Image size 2352x1568.
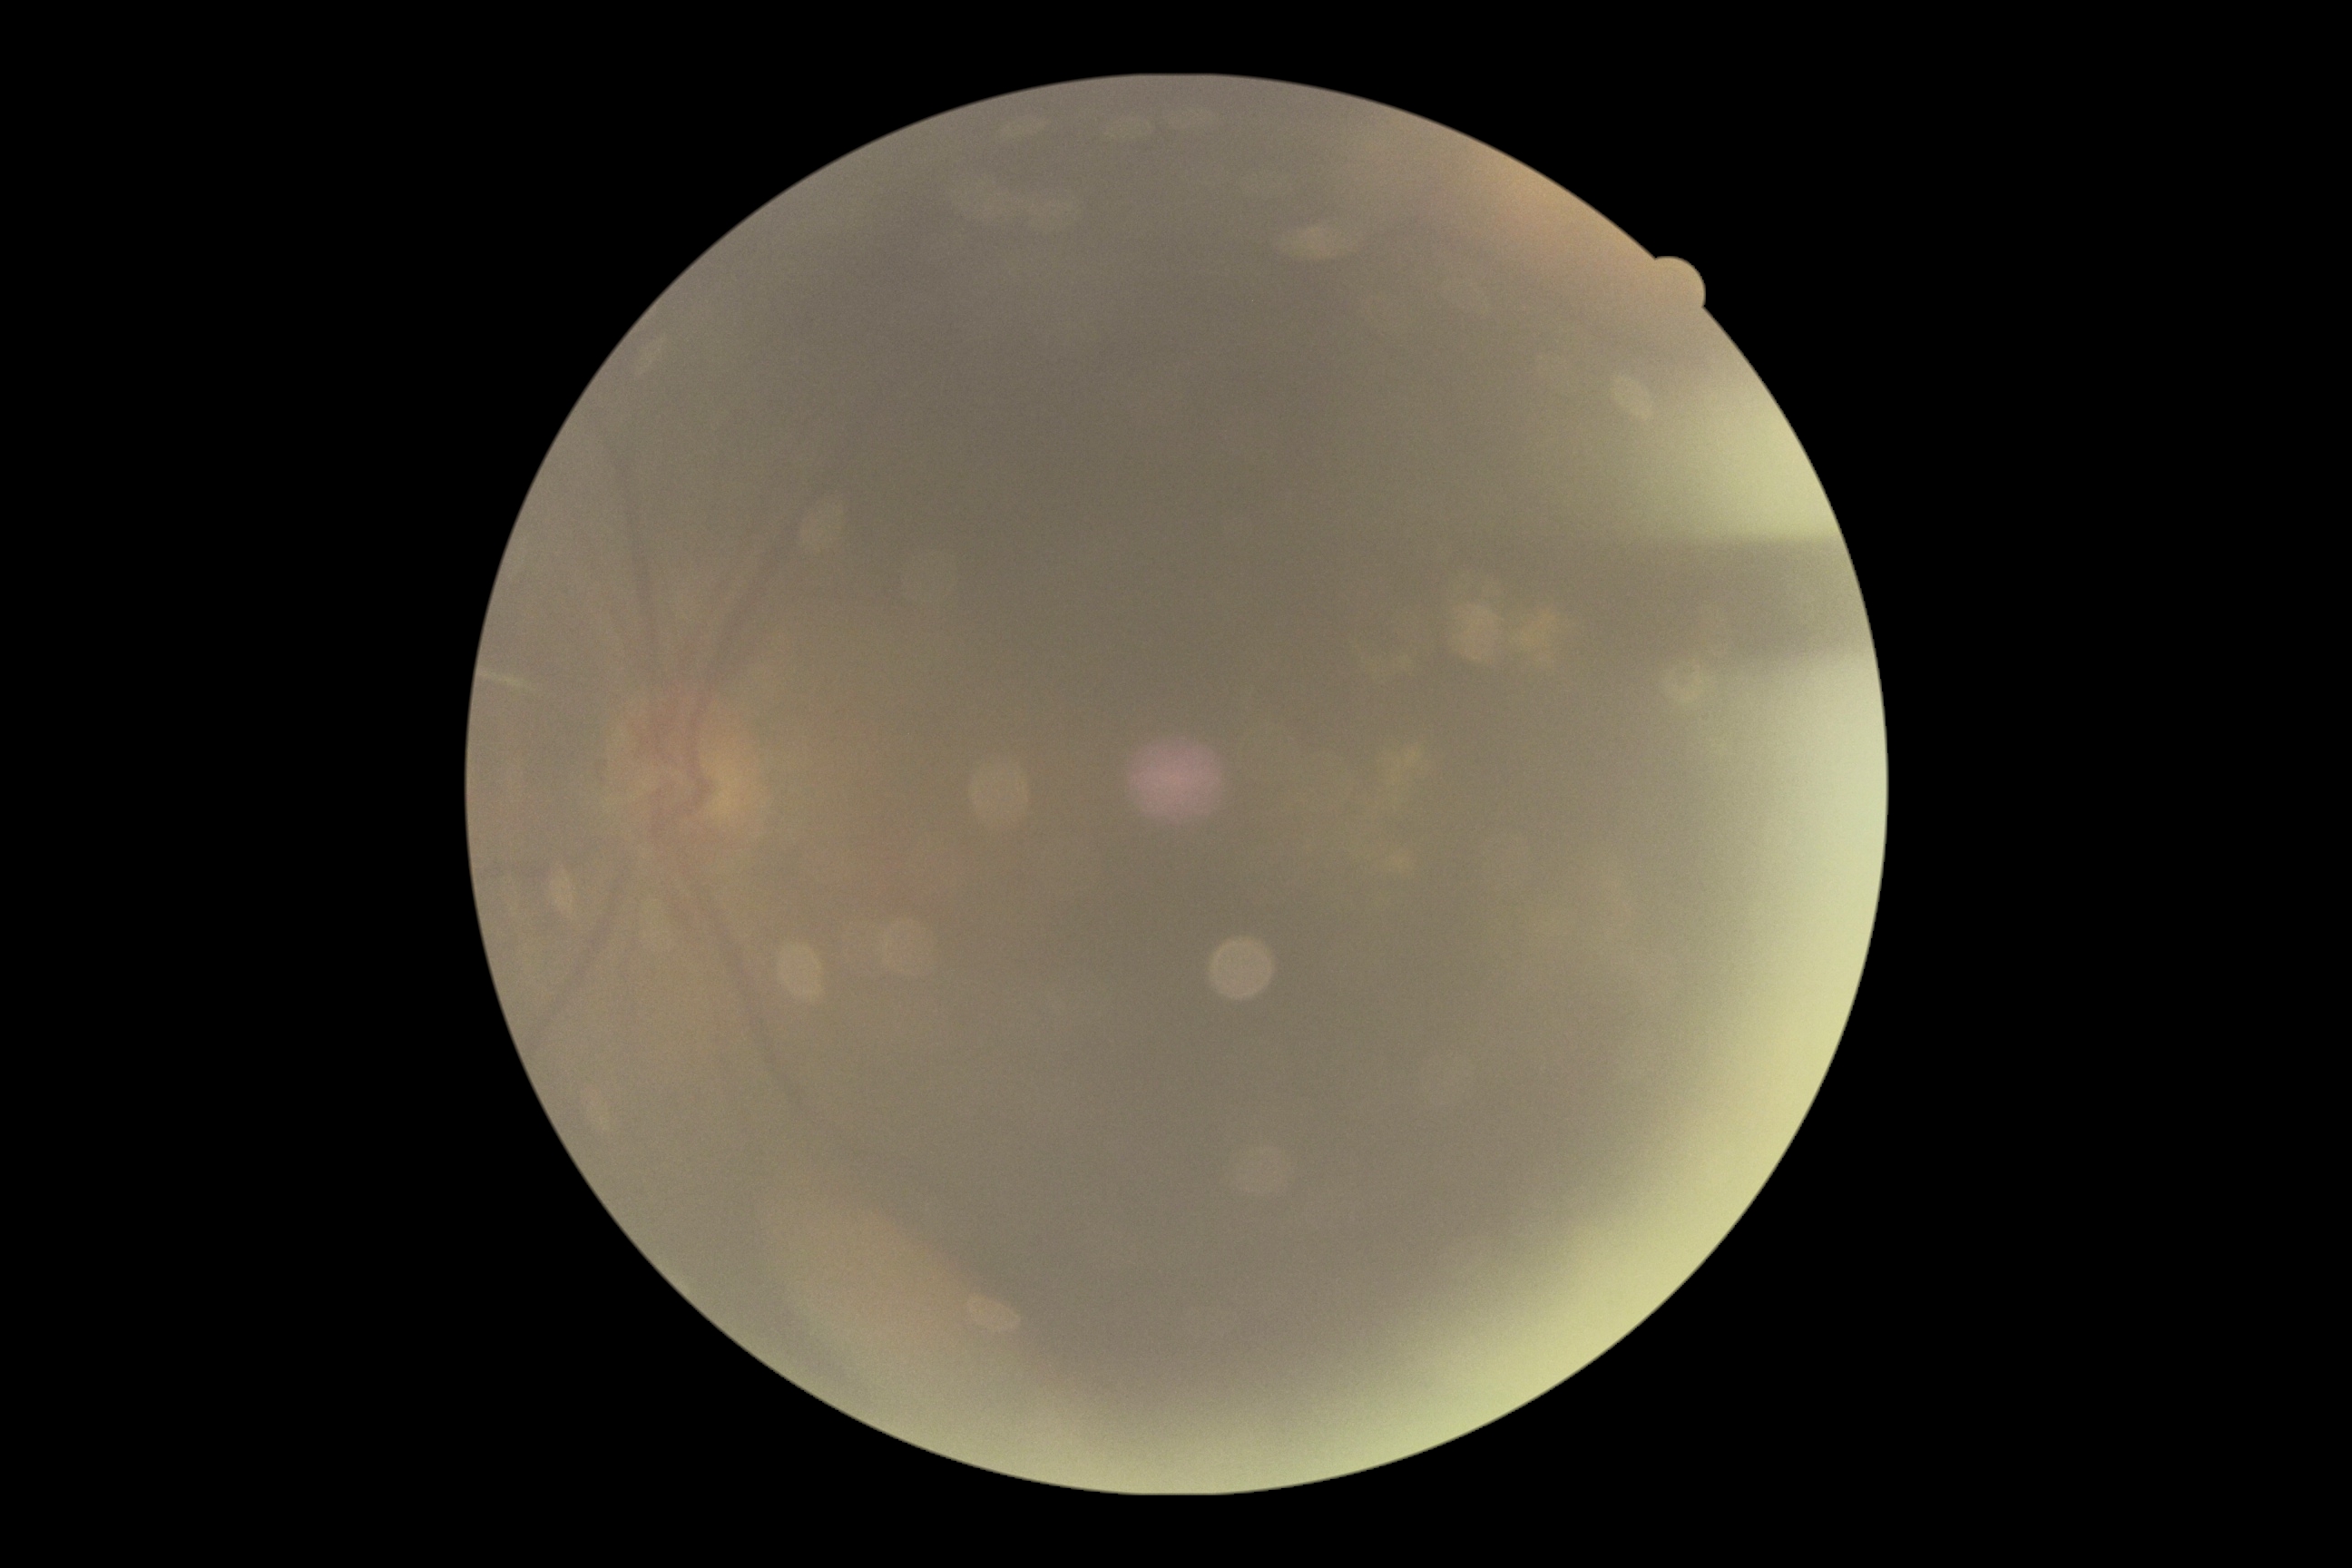
Ungradable image — DR severity cannot be determined. DR is ungradable due to poor image quality.